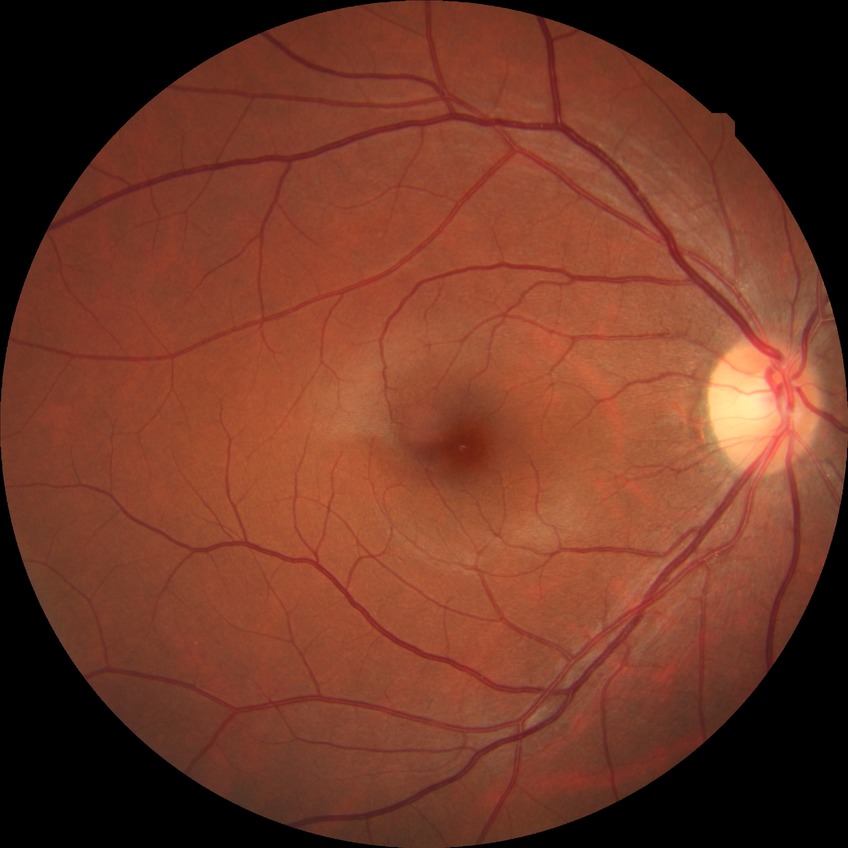

diabetic retinopathy (DR): NDR (no diabetic retinopathy).